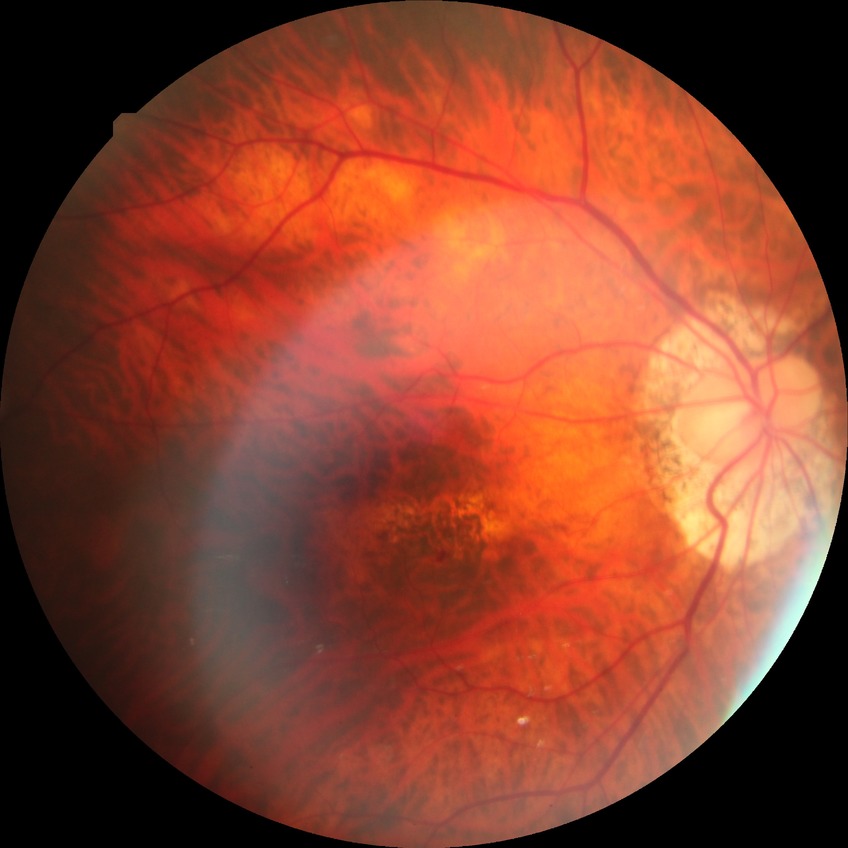 Modified Davis grading is no diabetic retinopathy.